DR severity per modified Davis staging
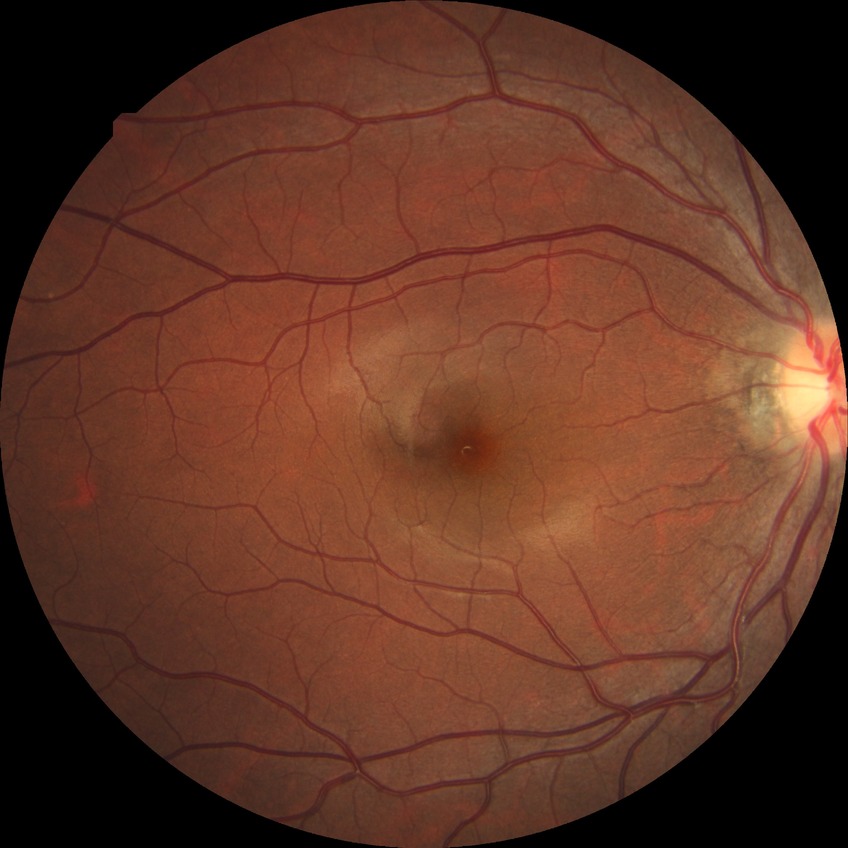
Diabetic retinopathy (DR): NDR (no diabetic retinopathy).